CFP:
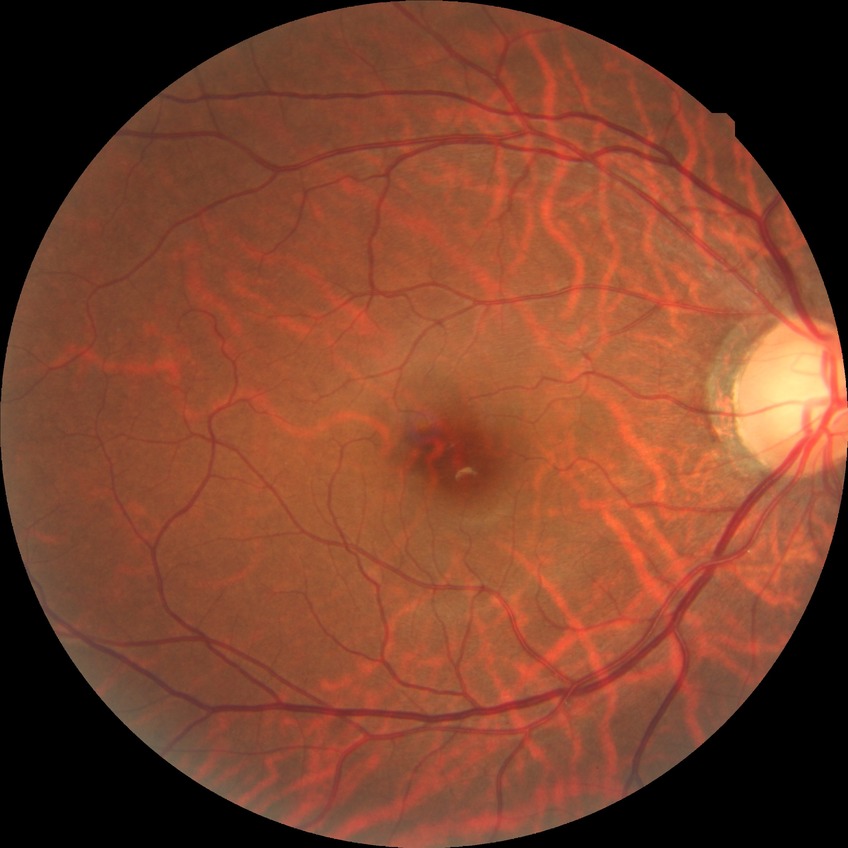
Diabetic retinopathy (DR): no diabetic retinopathy (NDR).